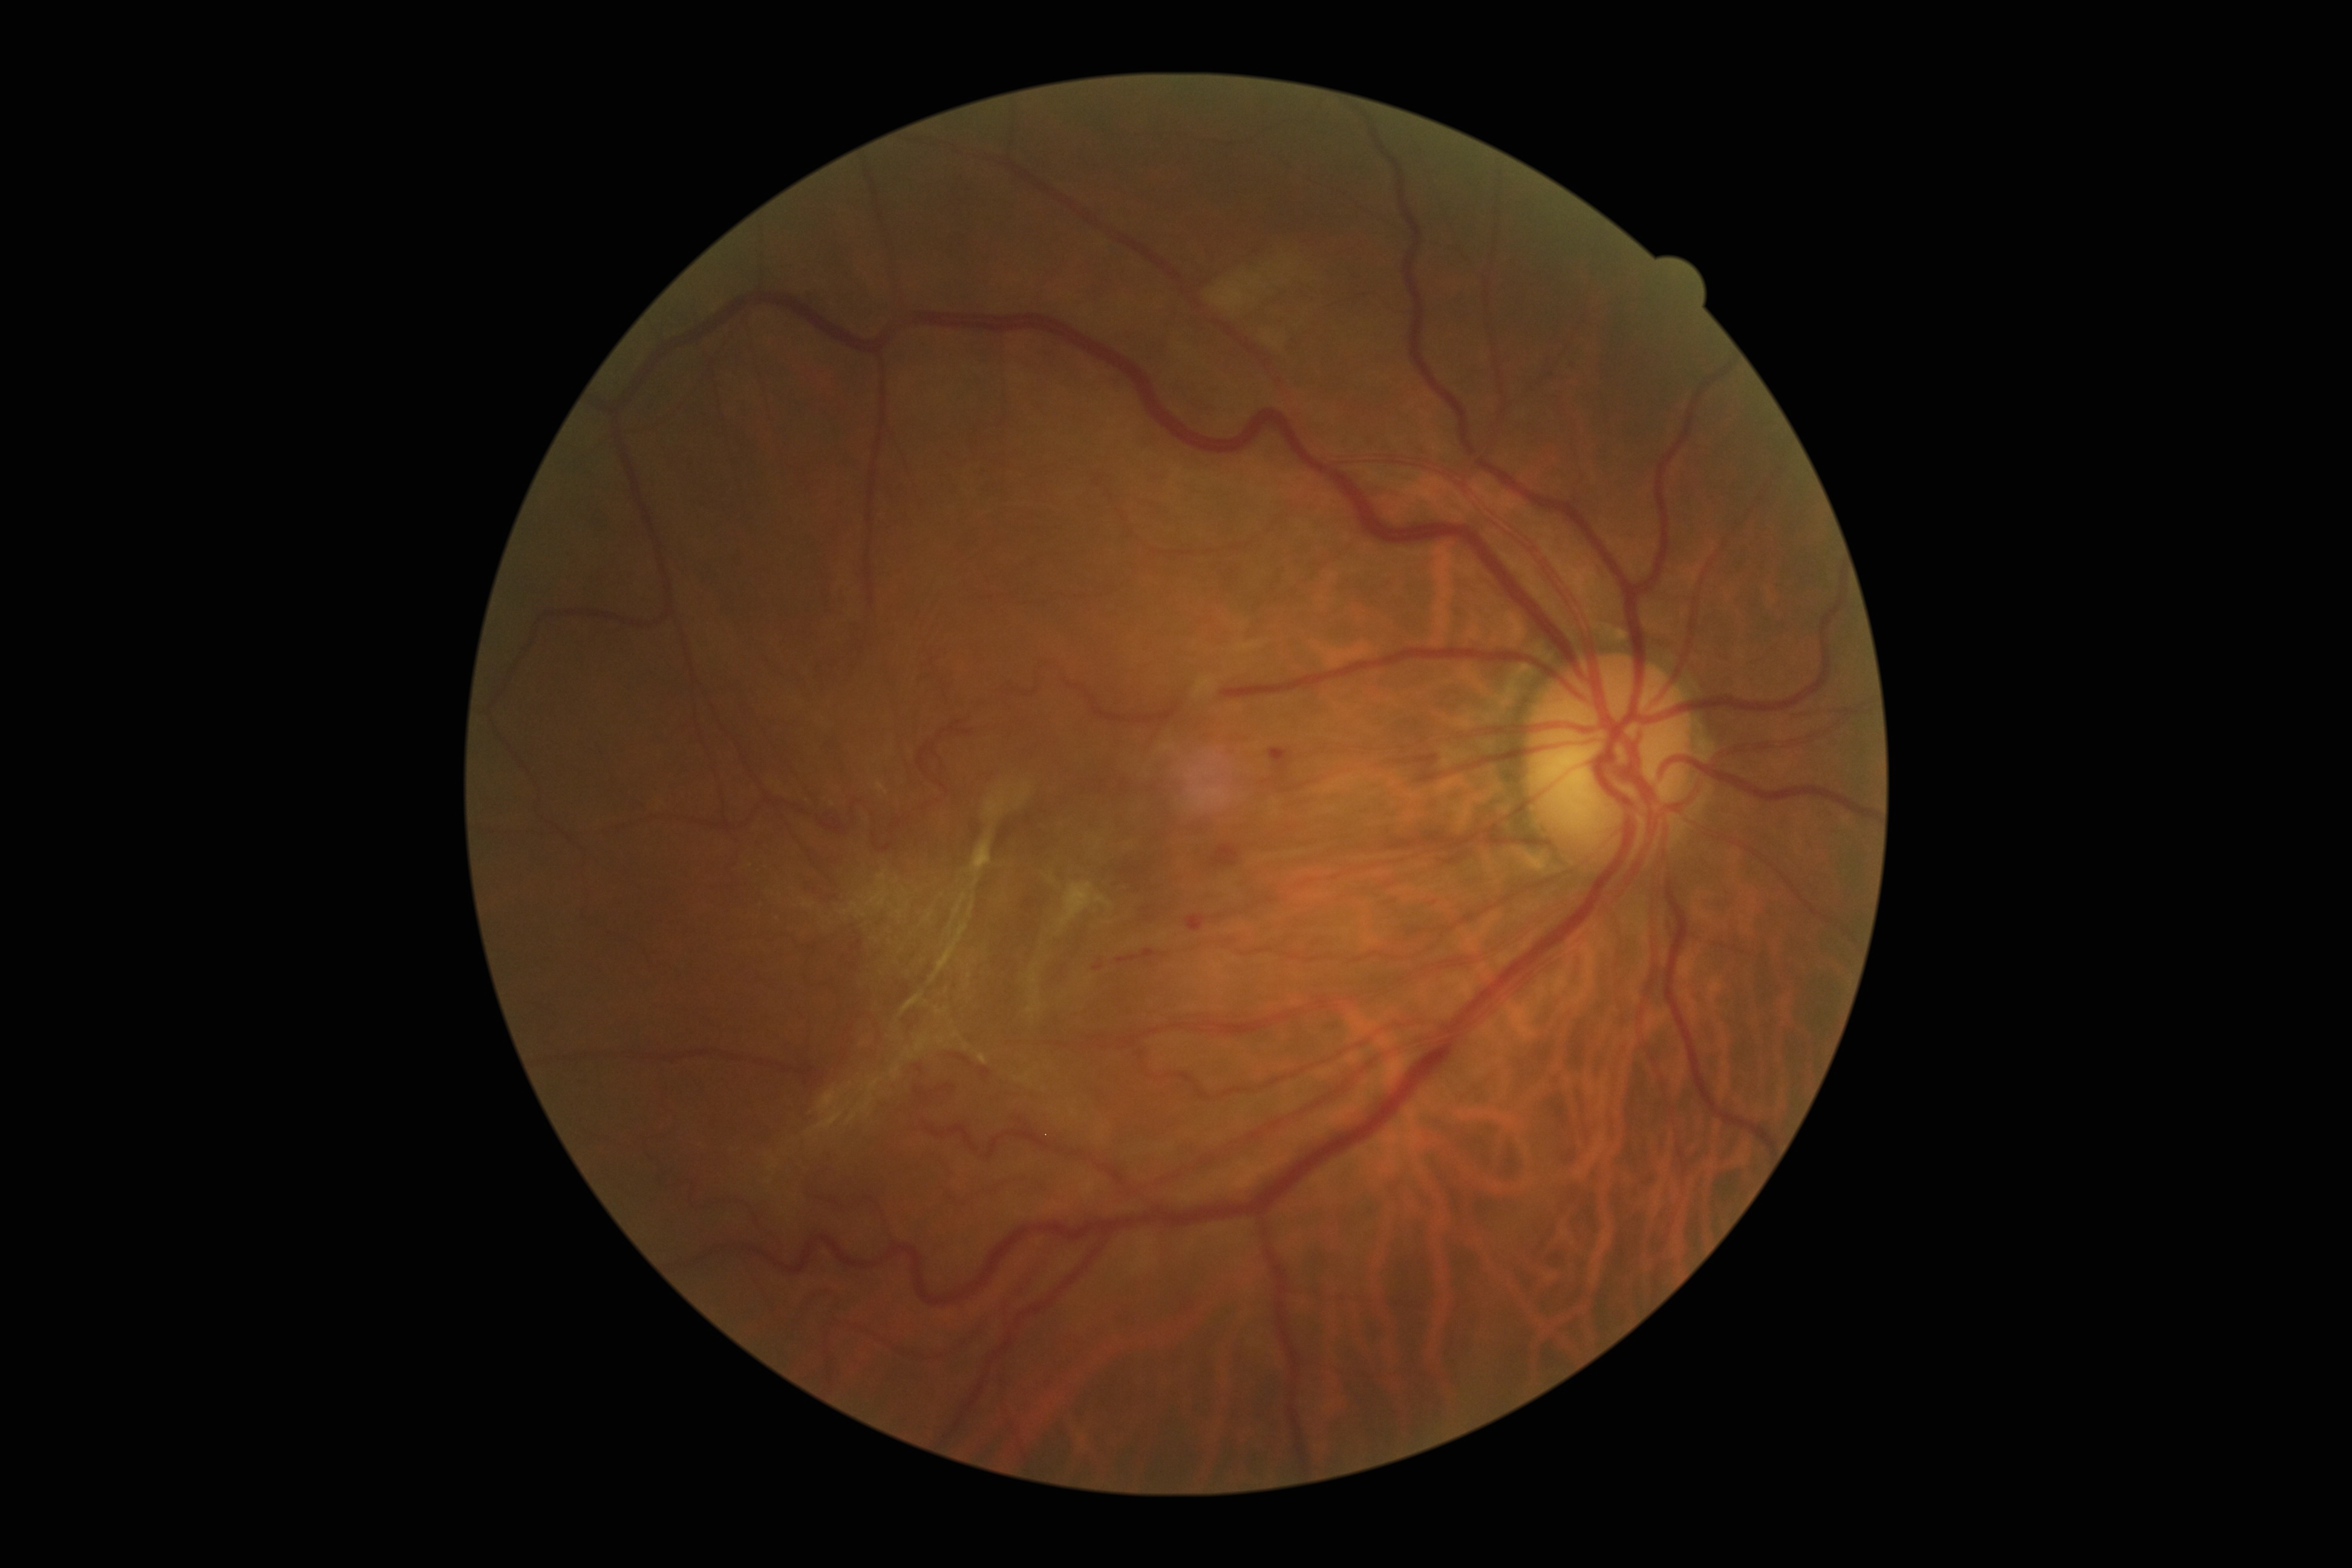
Retinopathy grade: proliferative diabetic retinopathy (4) — neovascularization and/or vitreous/pre-retinal hemorrhage.